Captured with the Clarity RetCam 3 (130° field of view); RetCam wide-field infant fundus image:
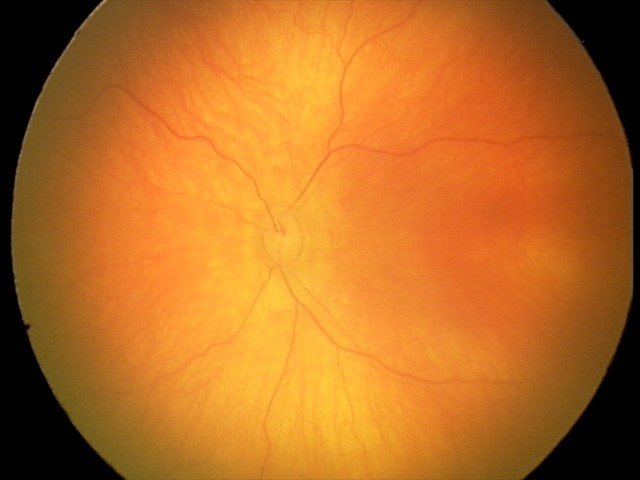
Examination with physiological retinal findings.